DR severity per modified Davis staging, color fundus image, camera: NIDEK AFC-230 — 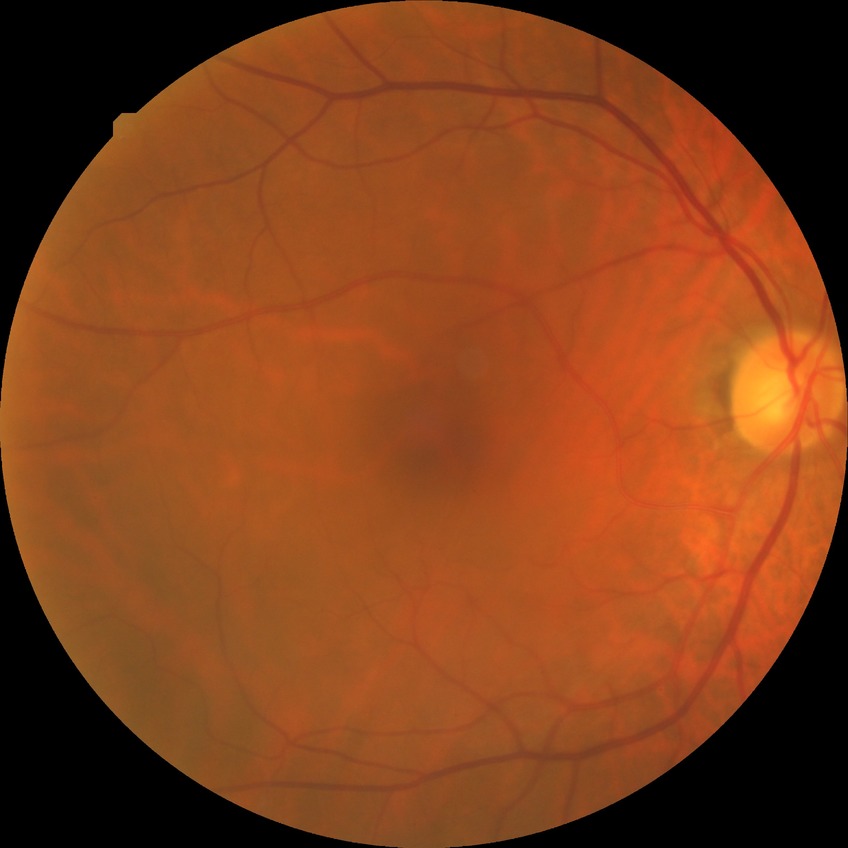

Diabetic retinopathy (DR) is no diabetic retinopathy (NDR).